Fundus photo: 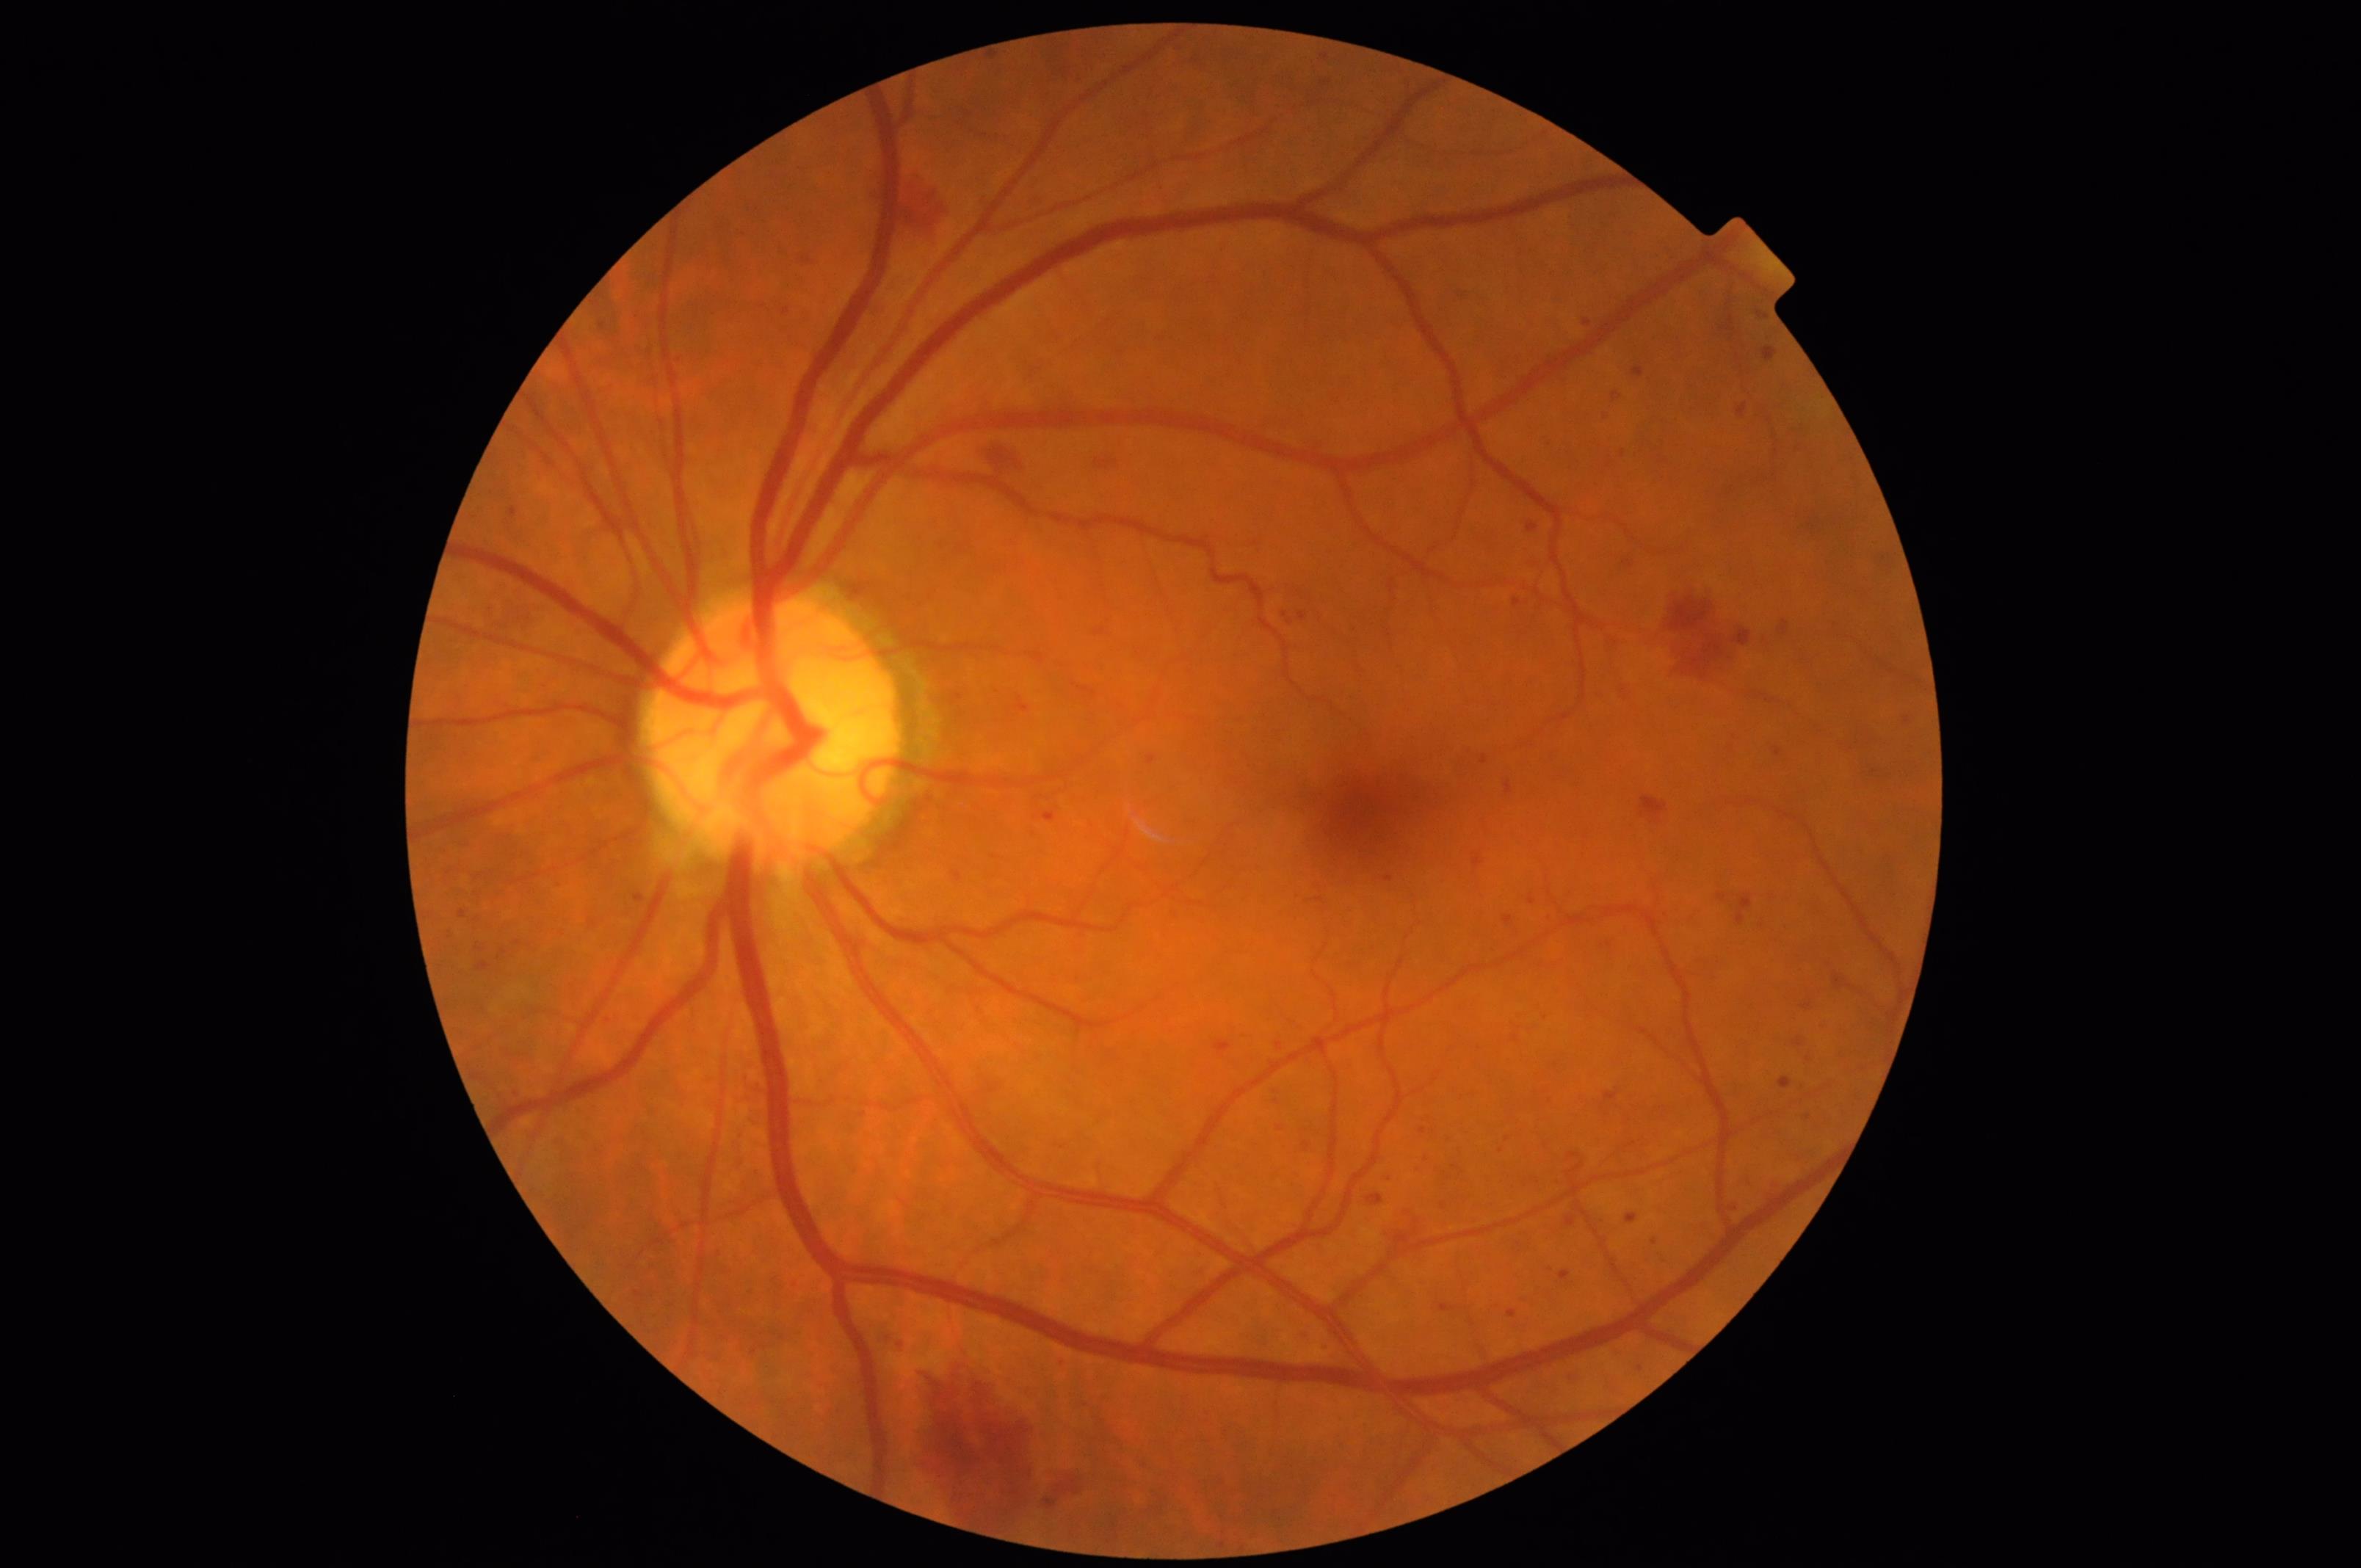 The image is clear.